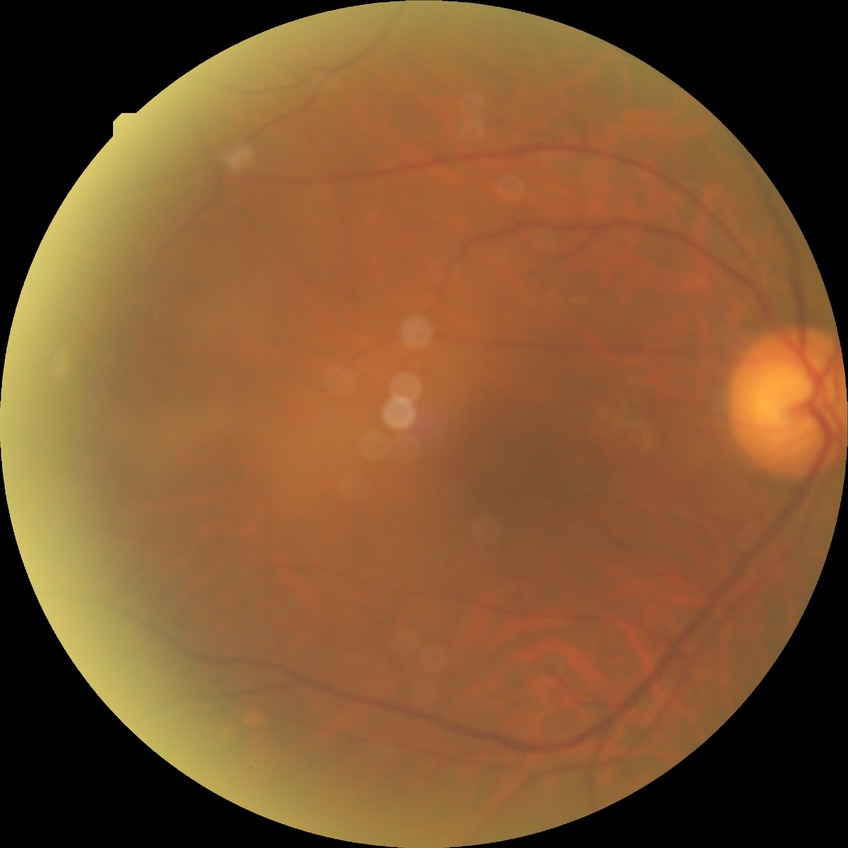

- retinopathy stage: no diabetic retinopathy